CFP; 45° field of view; 848 by 848 pixels; NIDEK AFC-230 fundus camera; without pupil dilation:
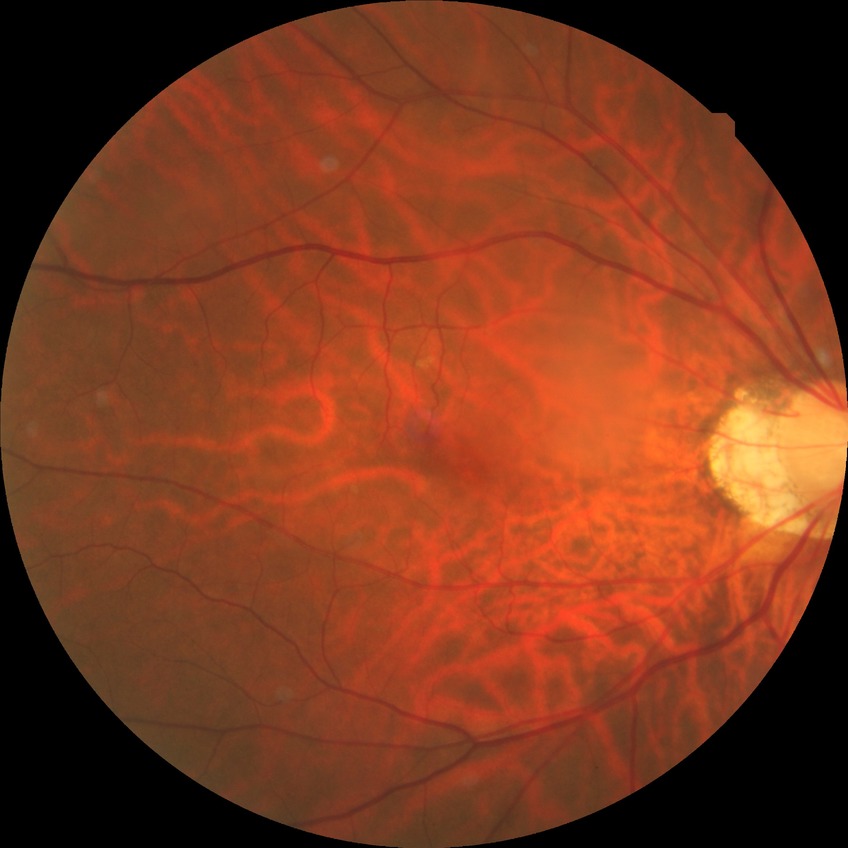
Diabetic retinopathy (DR): NDR (no diabetic retinopathy).